Woman. 65 years old. Axial length (AL): 22.66 mm: 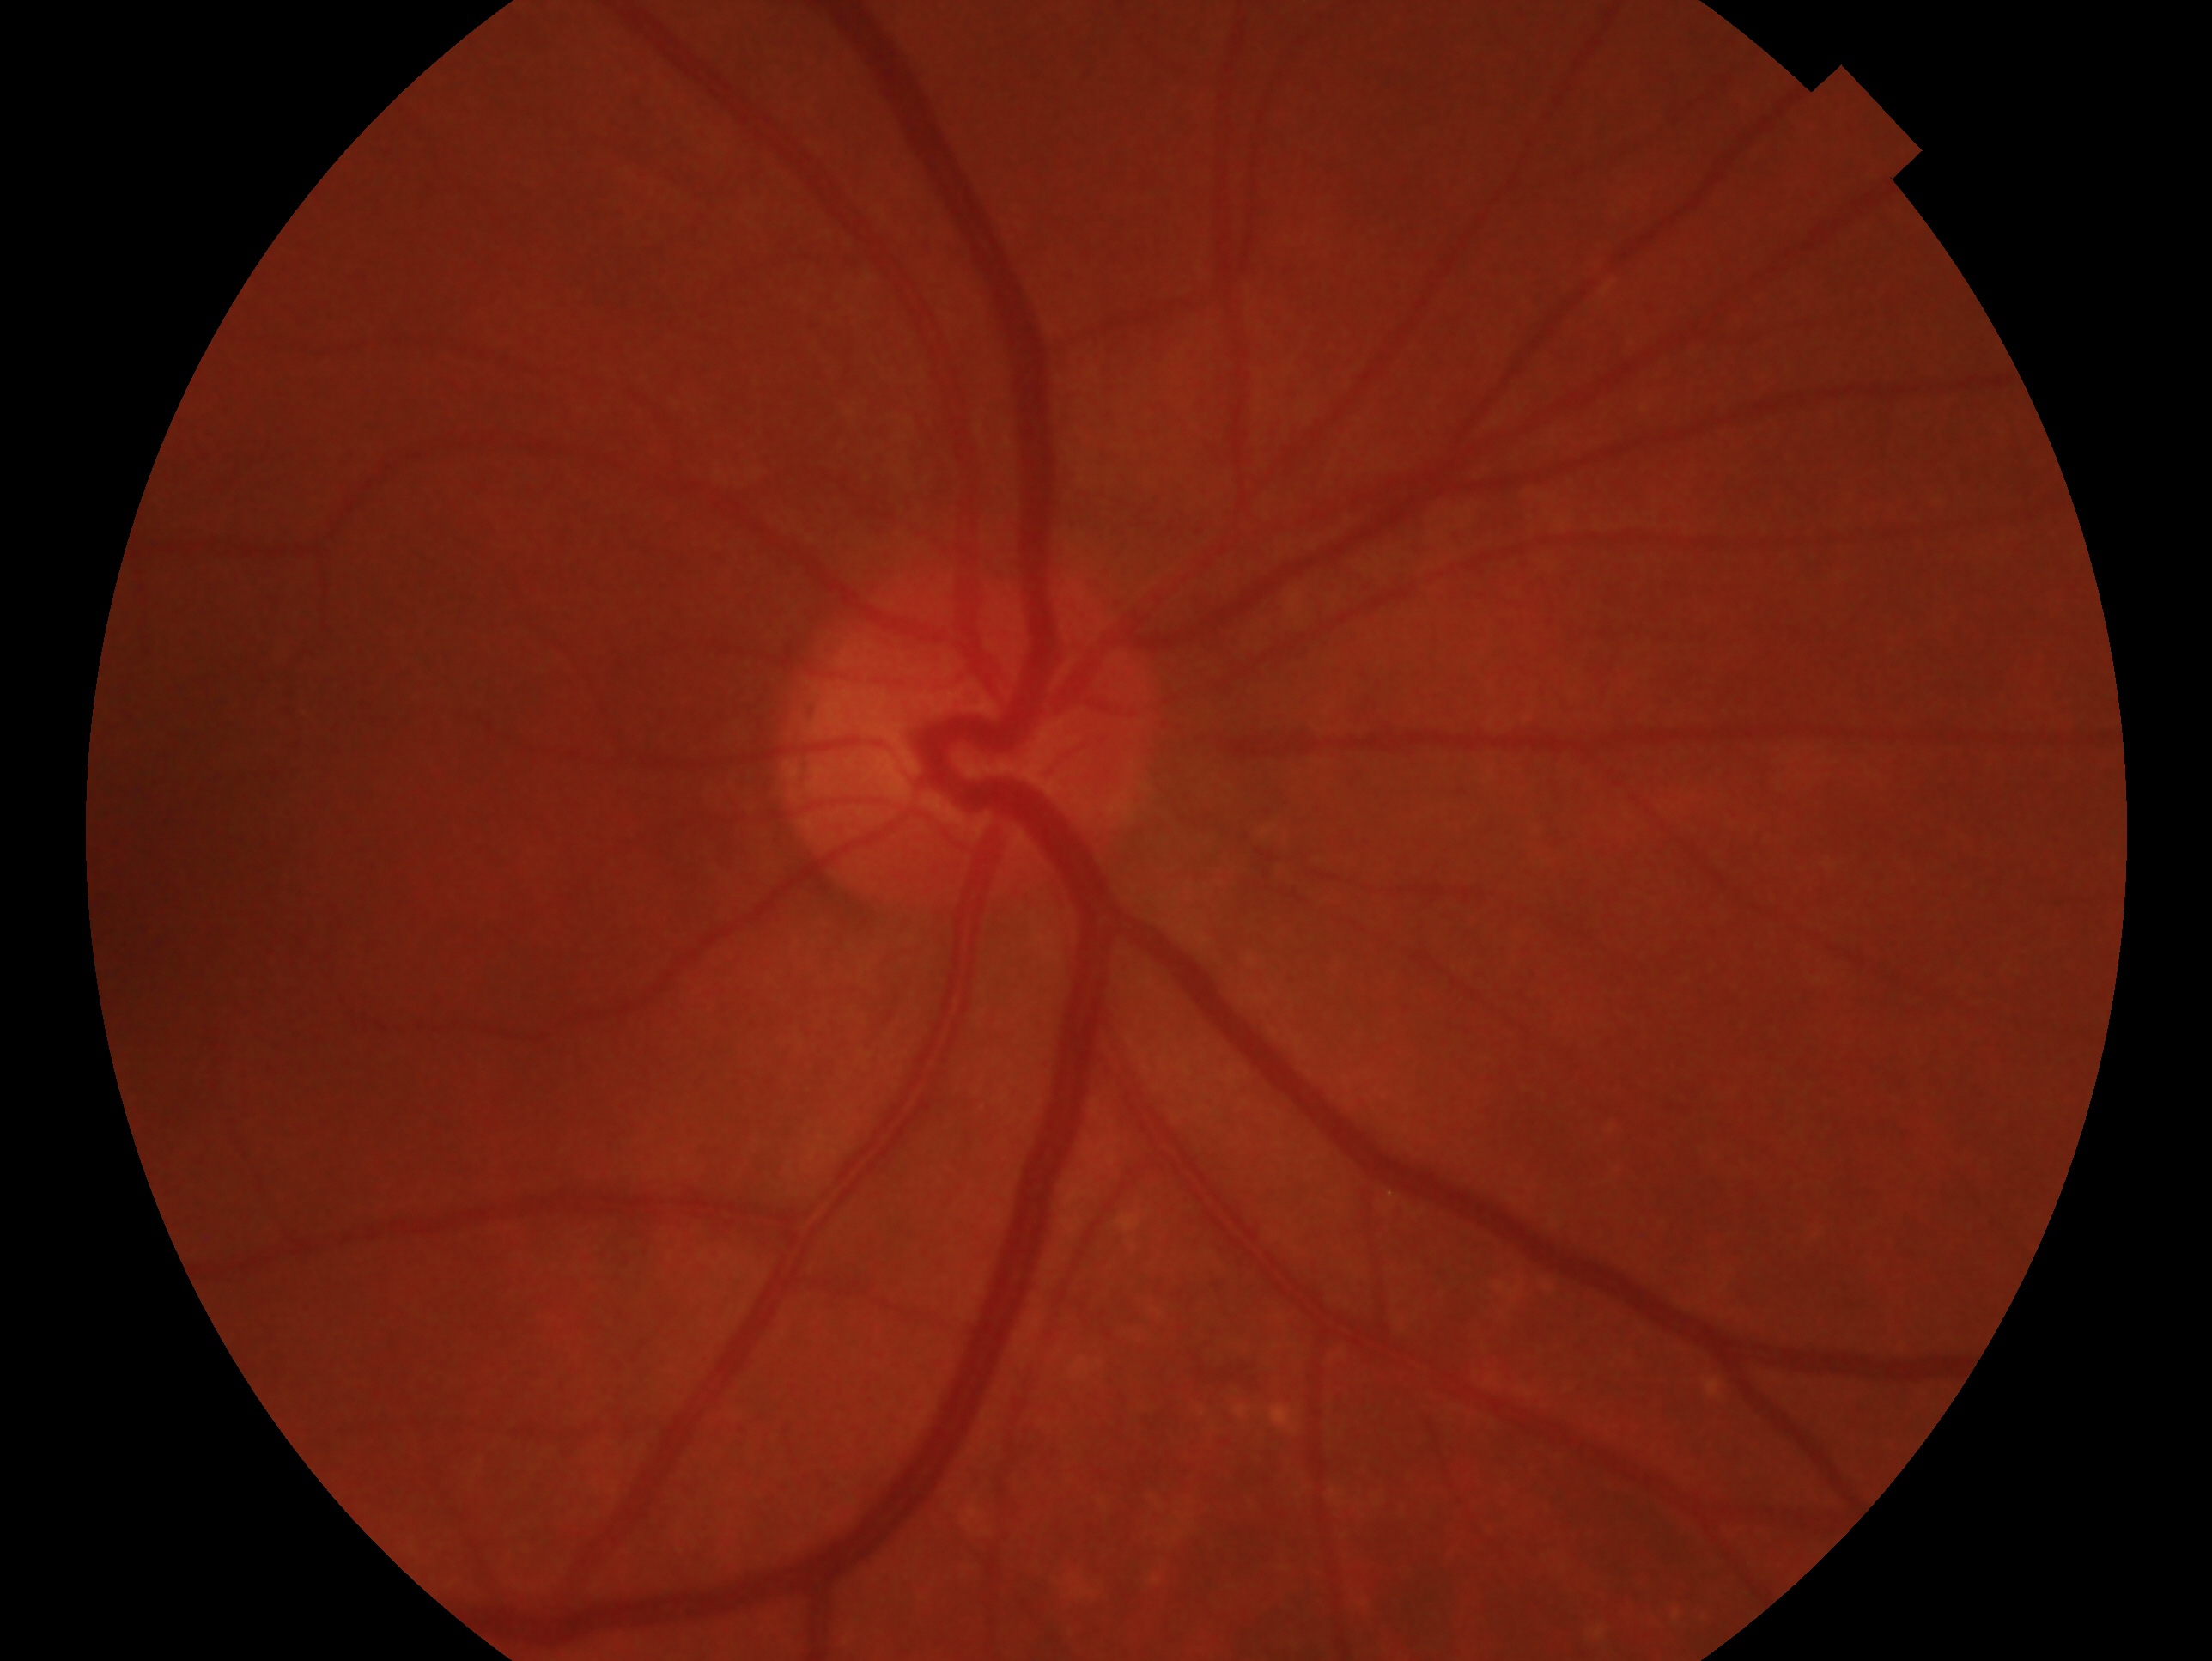
This is the OD.
Glaucoma status — no signs of glaucoma.